Color fundus photograph from a handheld portable camera:
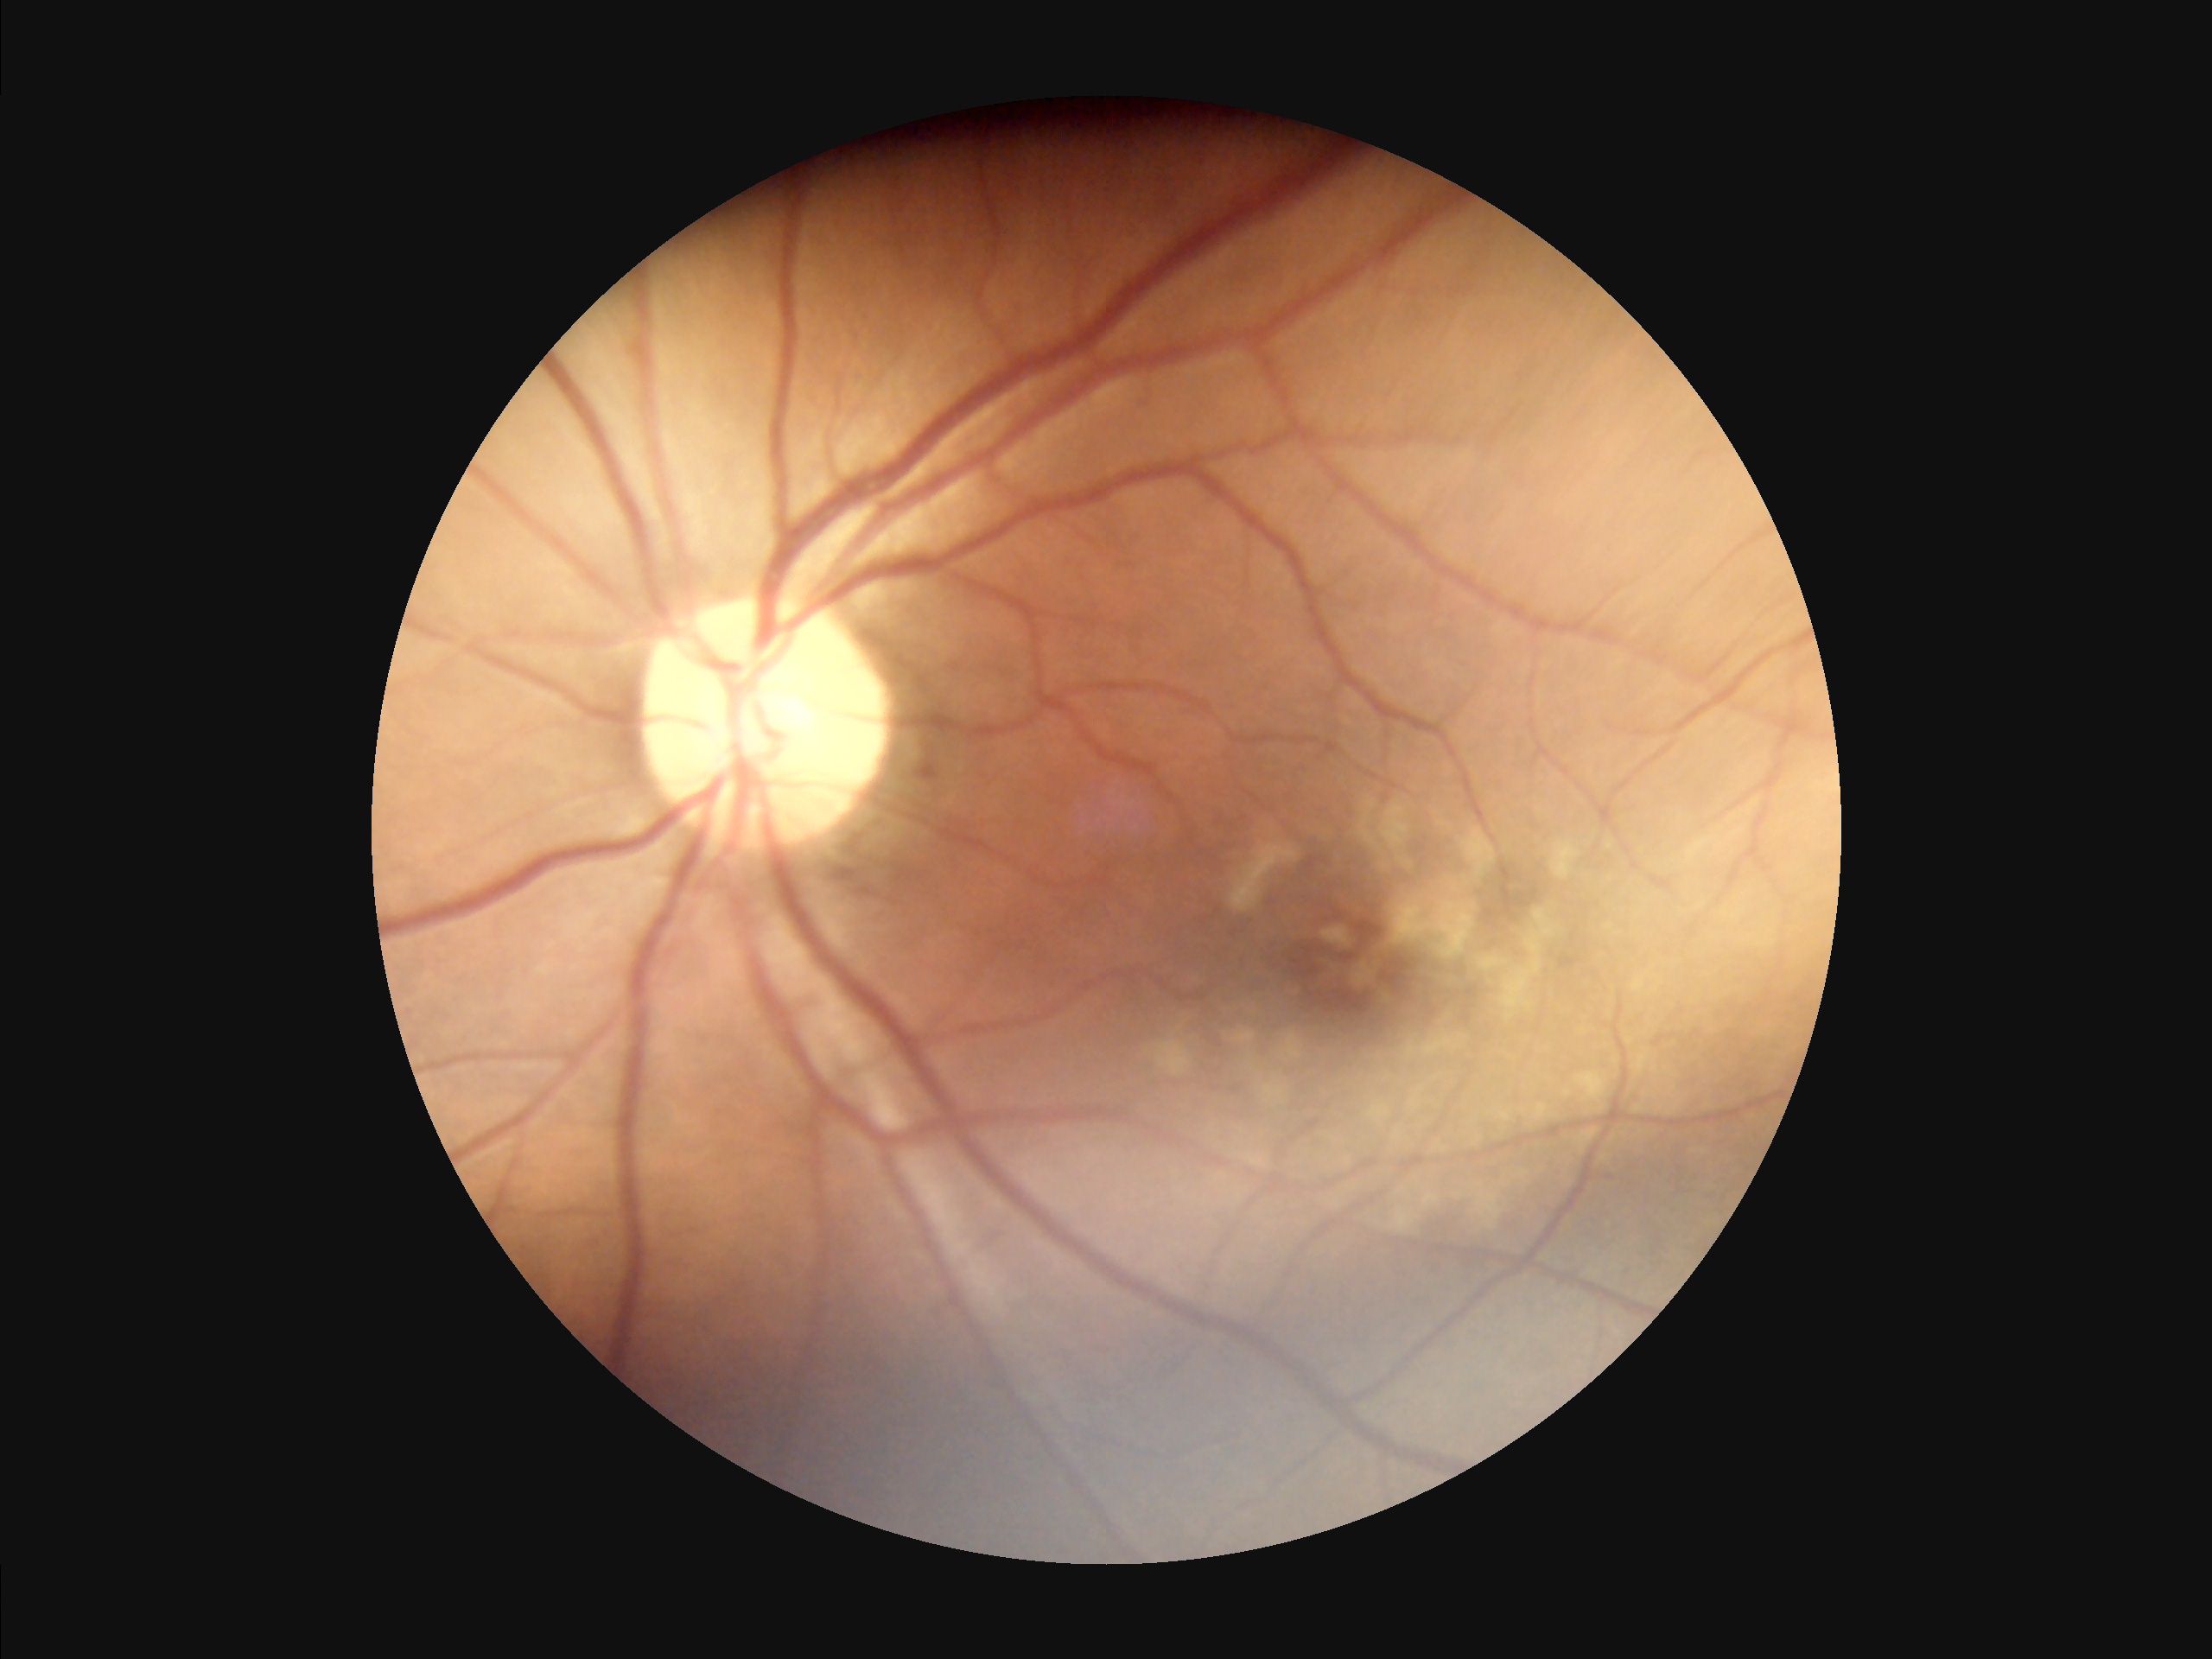
Image quality:
- sharpness: clear
- illumination/color: uneven
- overall: acceptable